Posterior pole photograph, without pupil dilation:
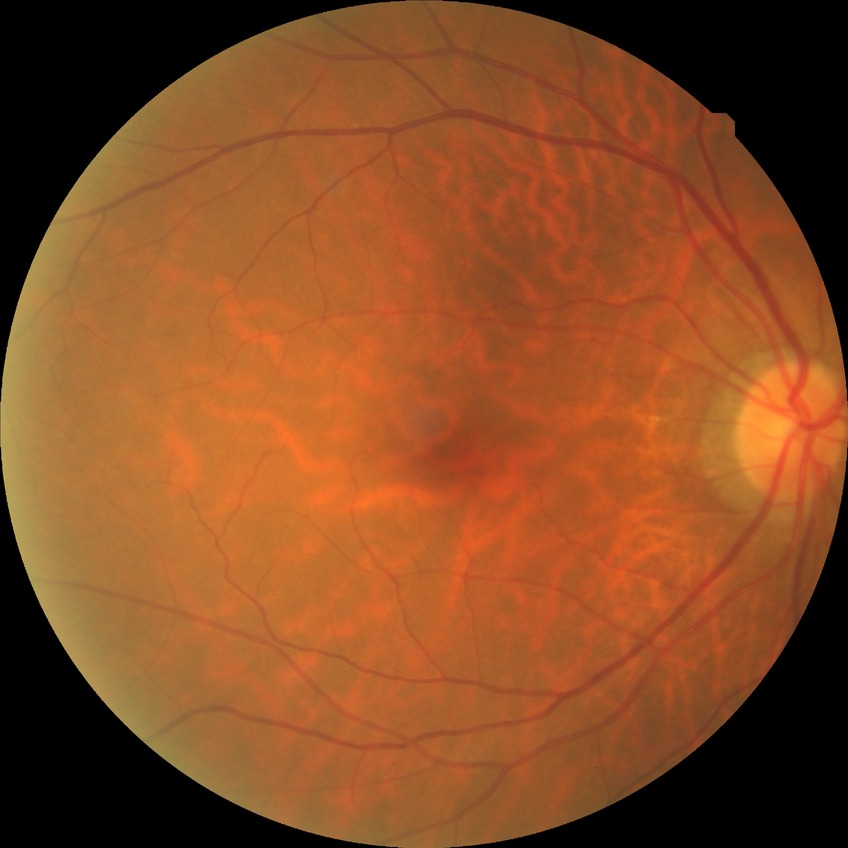 diabetic retinopathy (DR) = no diabetic retinopathy (NDR).